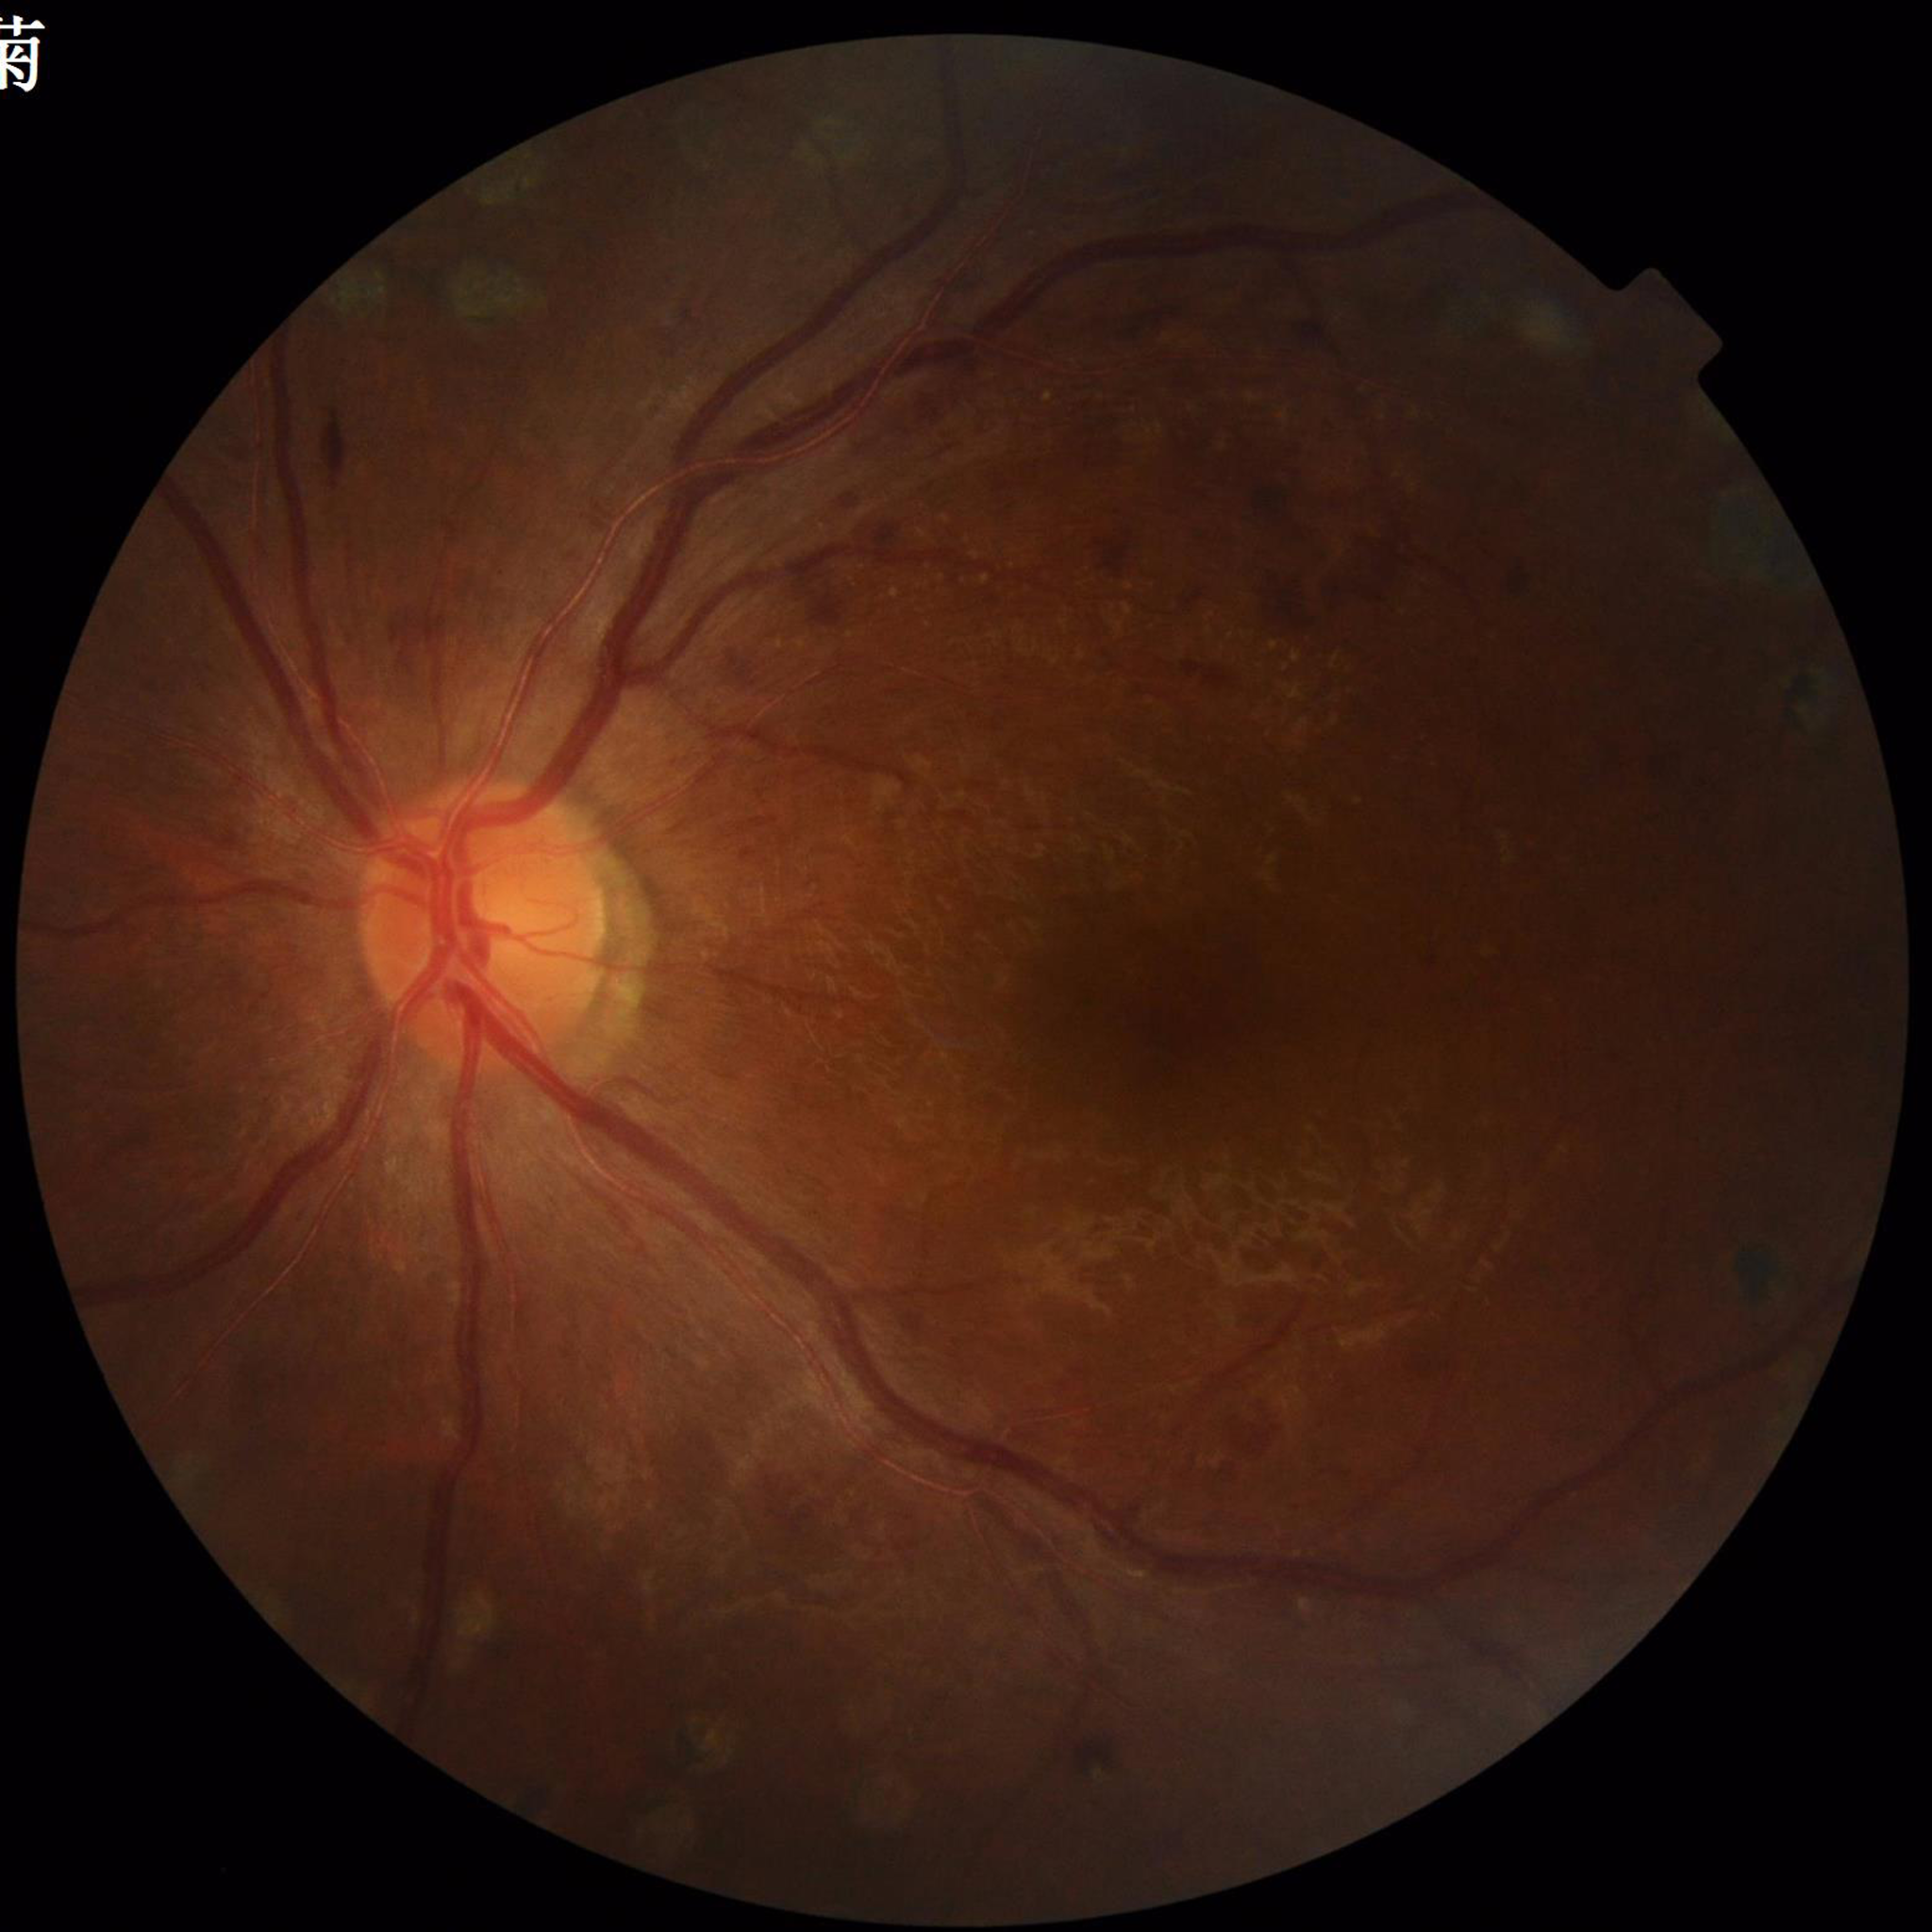 Color fundus photograph from a patient diagnosed with DR.
Automated quality assessment: no quality issues identified.